DR severity per modified Davis staging:
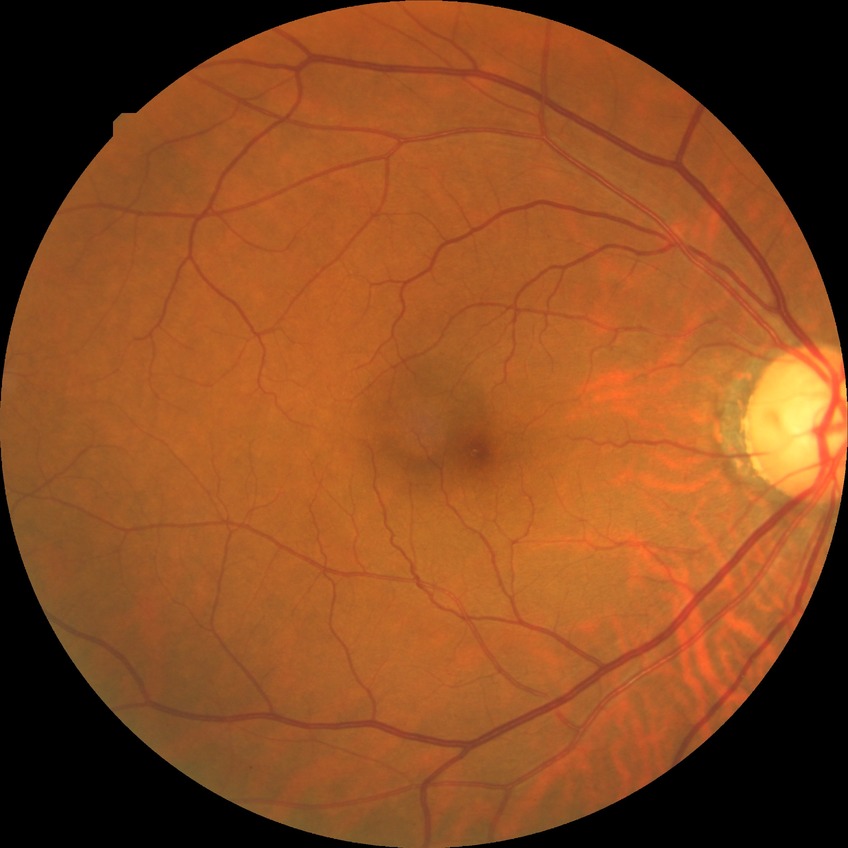 Annotations:
• Davis stage: NDR
• DR impression: no signs of DR